45-degree field of view — 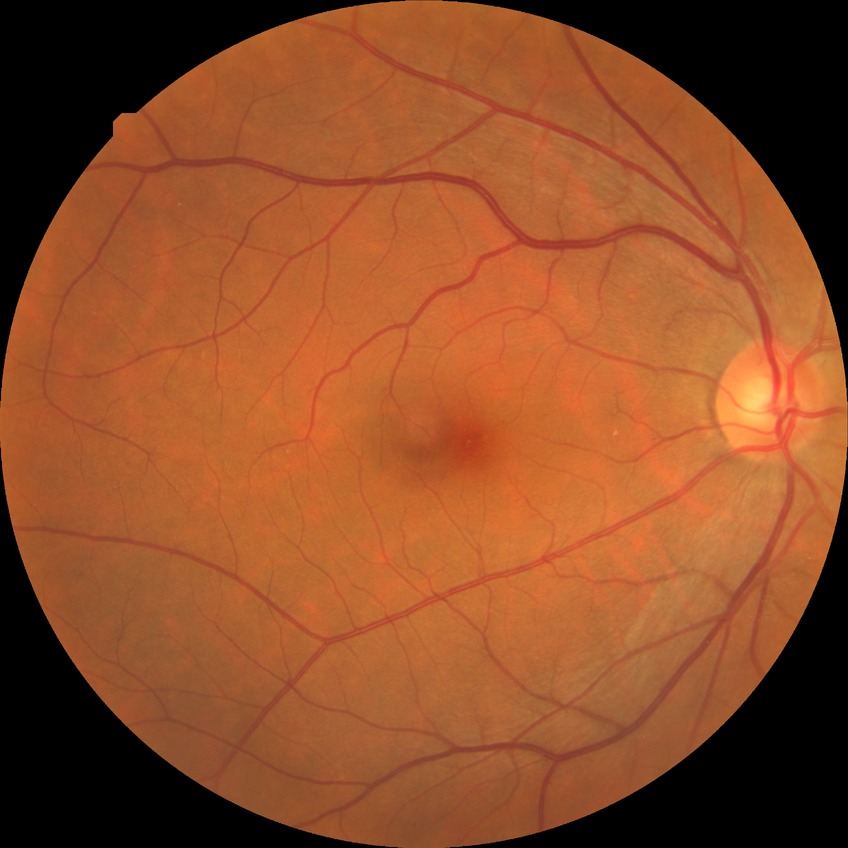 Findings:
- diabetic retinopathy (DR): NDR (no diabetic retinopathy)